Modified Davis classification
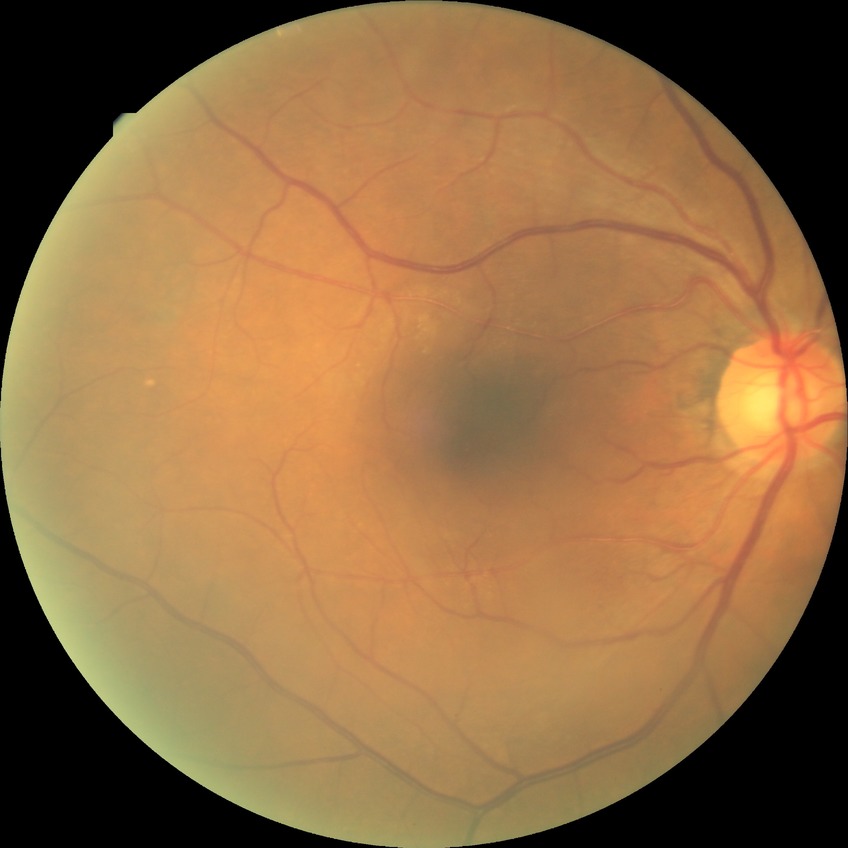

diabetic retinopathy severity = no diabetic retinopathy.